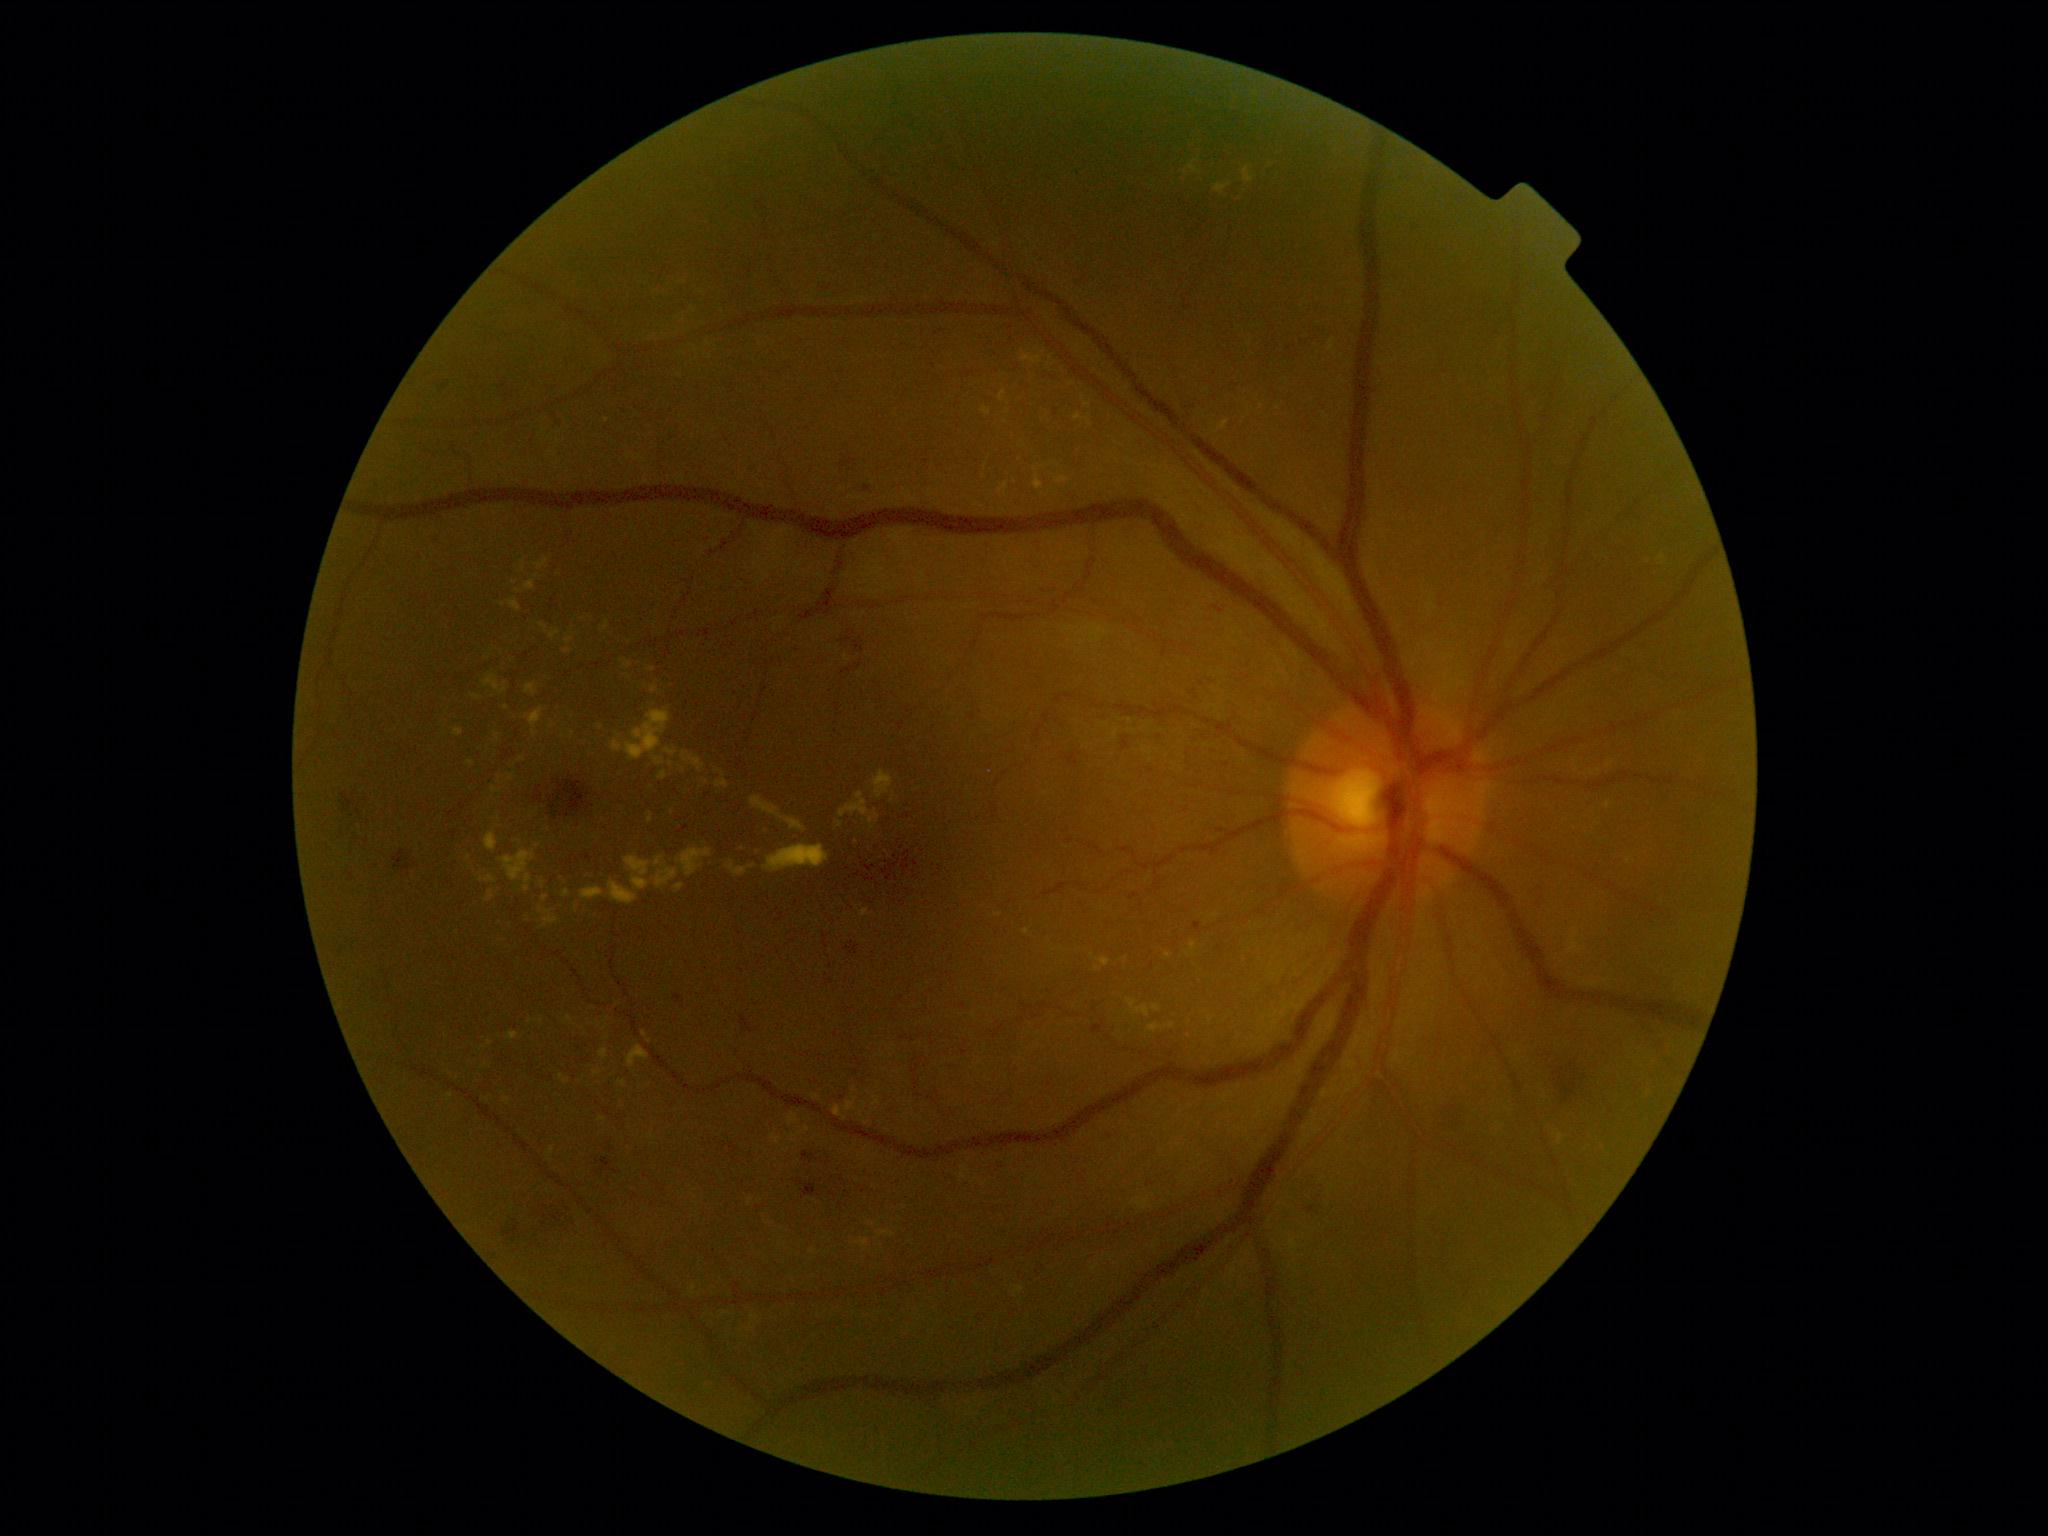
partial: true
dr_grade: 2
dr_grade_name: moderate NPDR
lesions:
  he:
    - Rect(680, 826, 690, 833)
    - Rect(814, 279, 839, 294)
    - Rect(674, 995, 684, 1004)
    - Rect(1194, 924, 1201, 932)
    - Rect(429, 534, 446, 554)
    - Rect(1211, 604, 1228, 619)
    - Rect(803, 1184, 817, 1196)
    - Rect(1102, 1128, 1124, 1147)
    - Rect(538, 1207, 578, 1237)
    - Rect(537, 775, 598, 829)
    - Rect(855, 641, 865, 652)
    - Rect(340, 790, 363, 822)
  he_small_centers:
    - [x=842, y=1179]
    - [x=352, y=878]
  ex:
    - Rect(611, 710, 671, 762)
    - Rect(535, 557, 549, 570)
    - Rect(541, 879, 545, 888)
    - Rect(1074, 414, 1082, 421)
    - Rect(873, 1097, 880, 1107)
    - Rect(676, 883, 686, 893)
    - Rect(878, 1230, 895, 1237)
    - Rect(857, 1239, 869, 1250)
    - Rect(610, 881, 638, 905)
    - Rect(600, 1050, 608, 1060)
    - Rect(539, 908, 559, 929)
    - Rect(718, 770, 726, 776)
  ex_small_centers:
    - [x=683, y=770]
    - [x=573, y=734]
    - [x=1629, y=861]
    - [x=893, y=801]
    - [x=866, y=1148]
    - [x=607, y=421]